50° FOV · retinal fundus photograph · macula-centered:
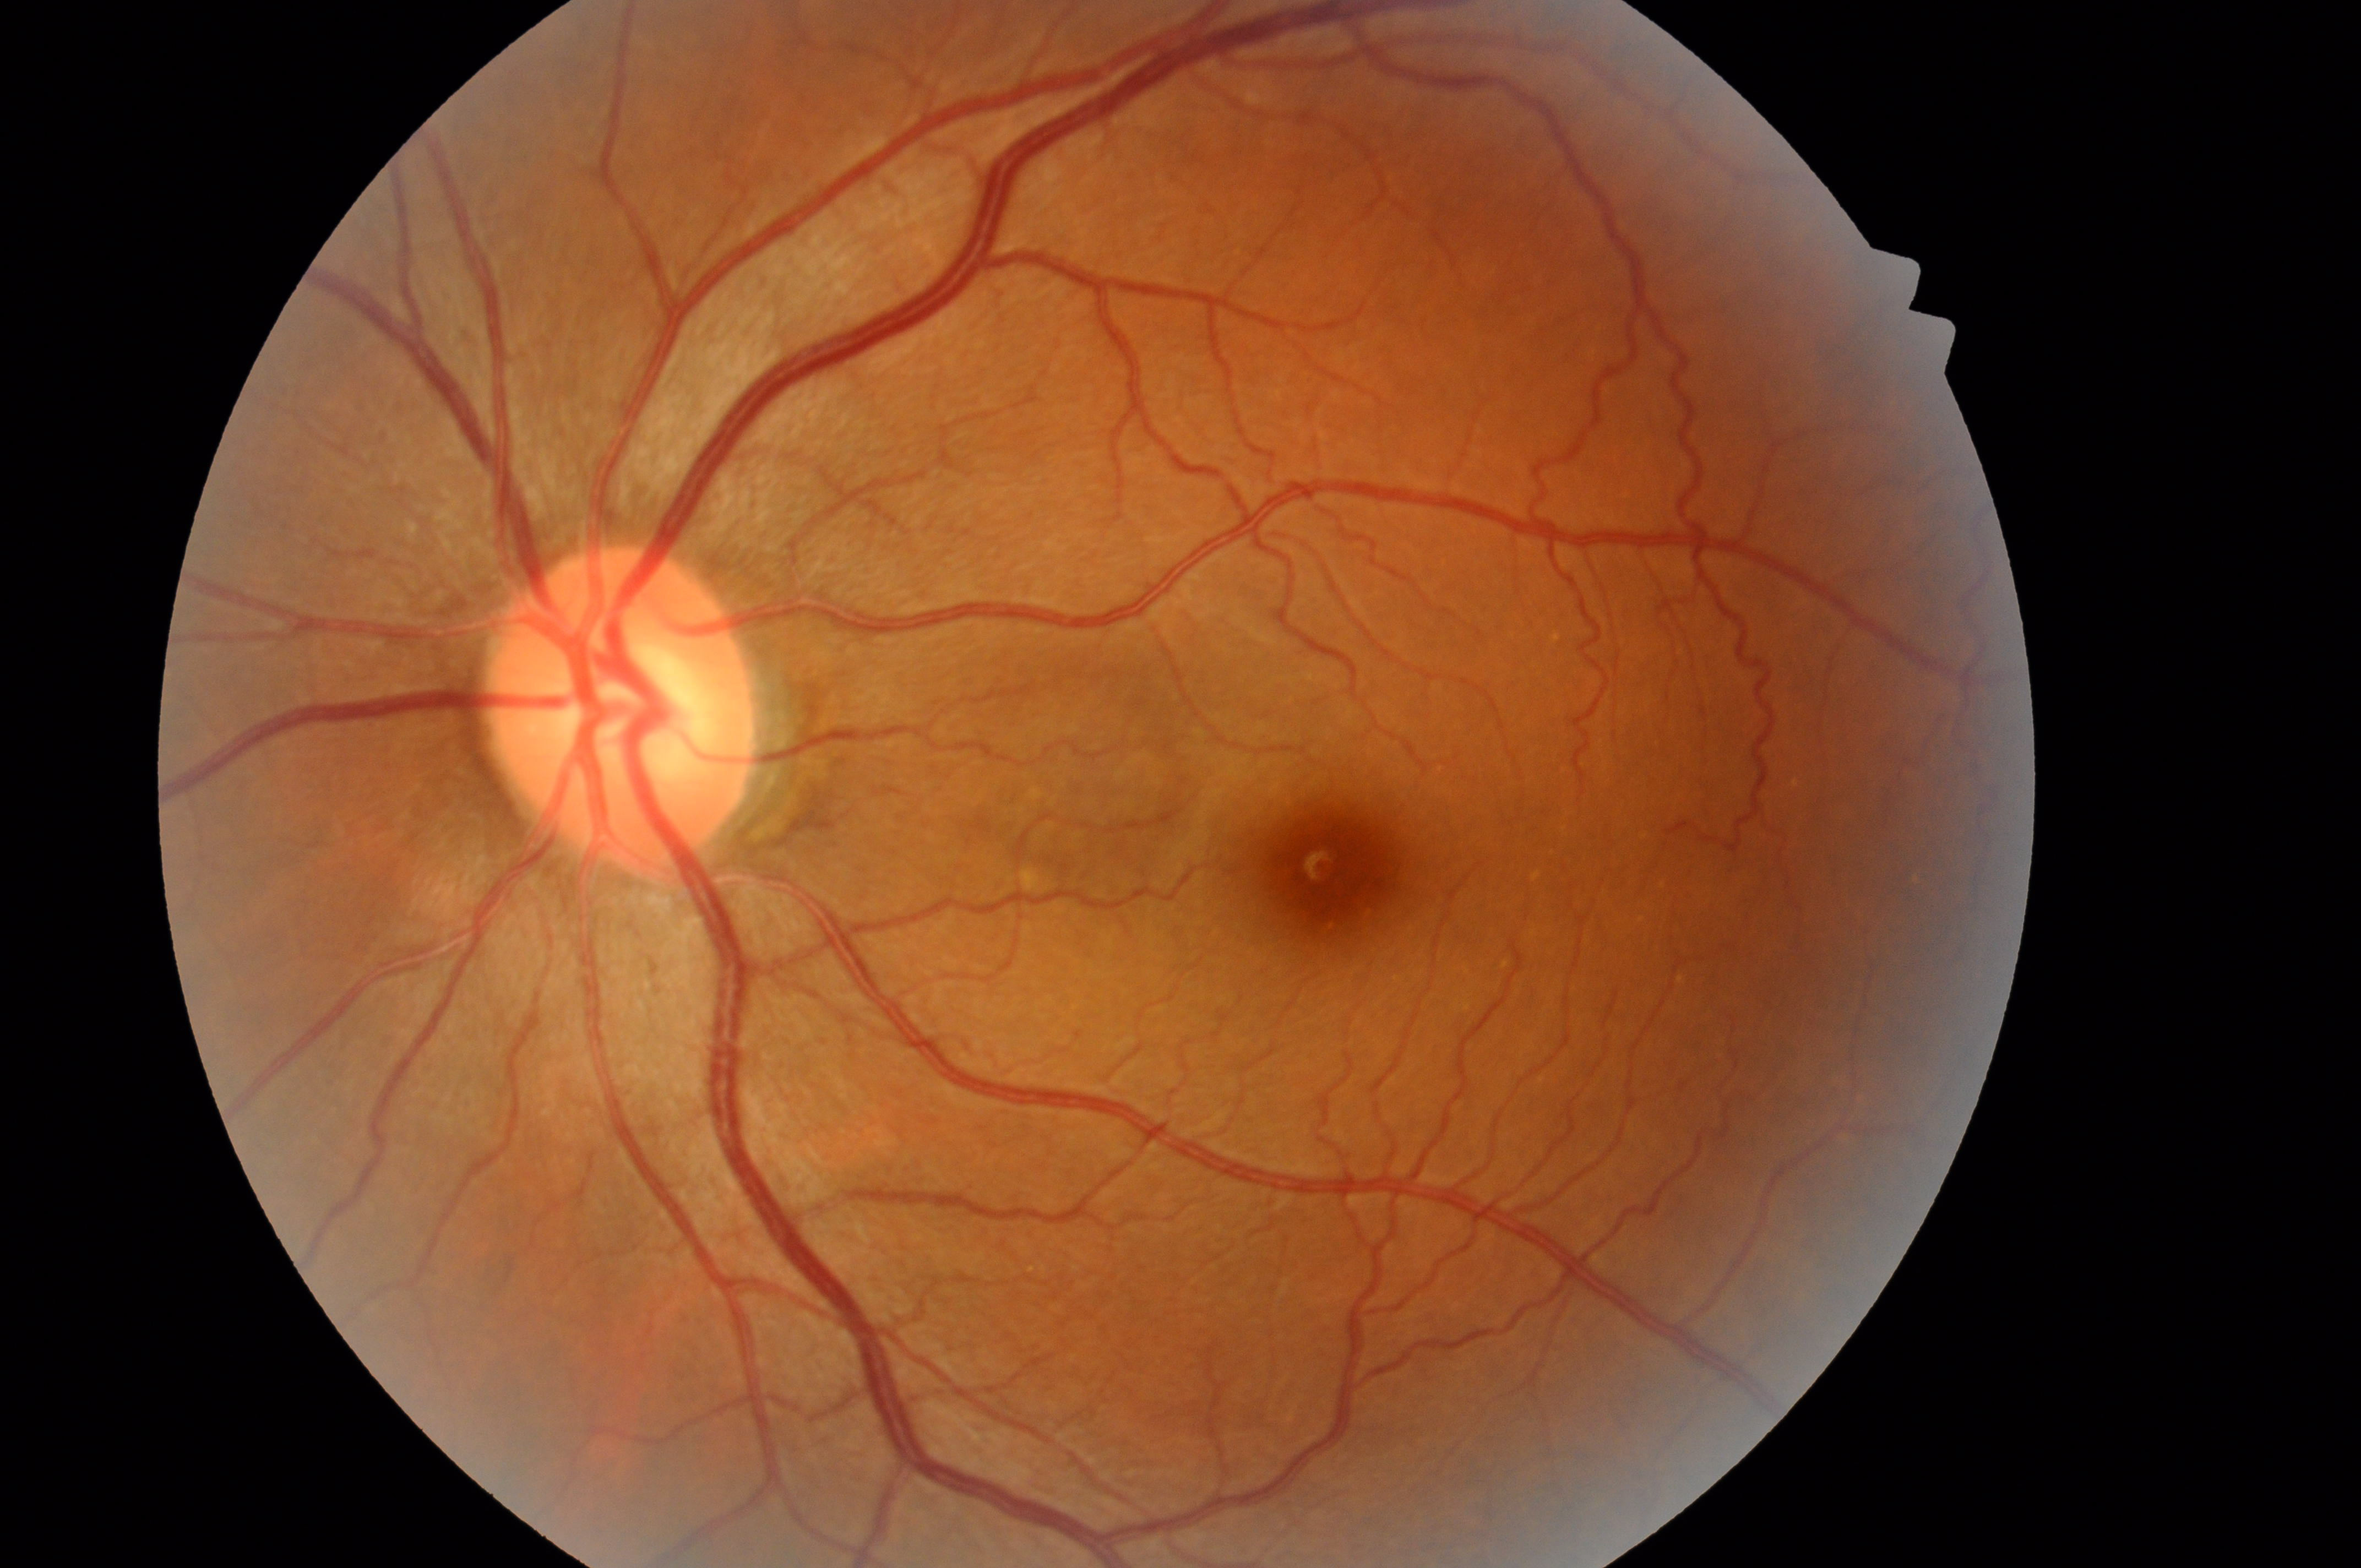 Annotations:
* optic nerve head · 617, 715
* DME risk · 0/2
* laterality · the left eye
* DR stage · grade 0
* macular center · 1341, 870
* DR impression · No diabetic retinal disease findings